2089x1764px.
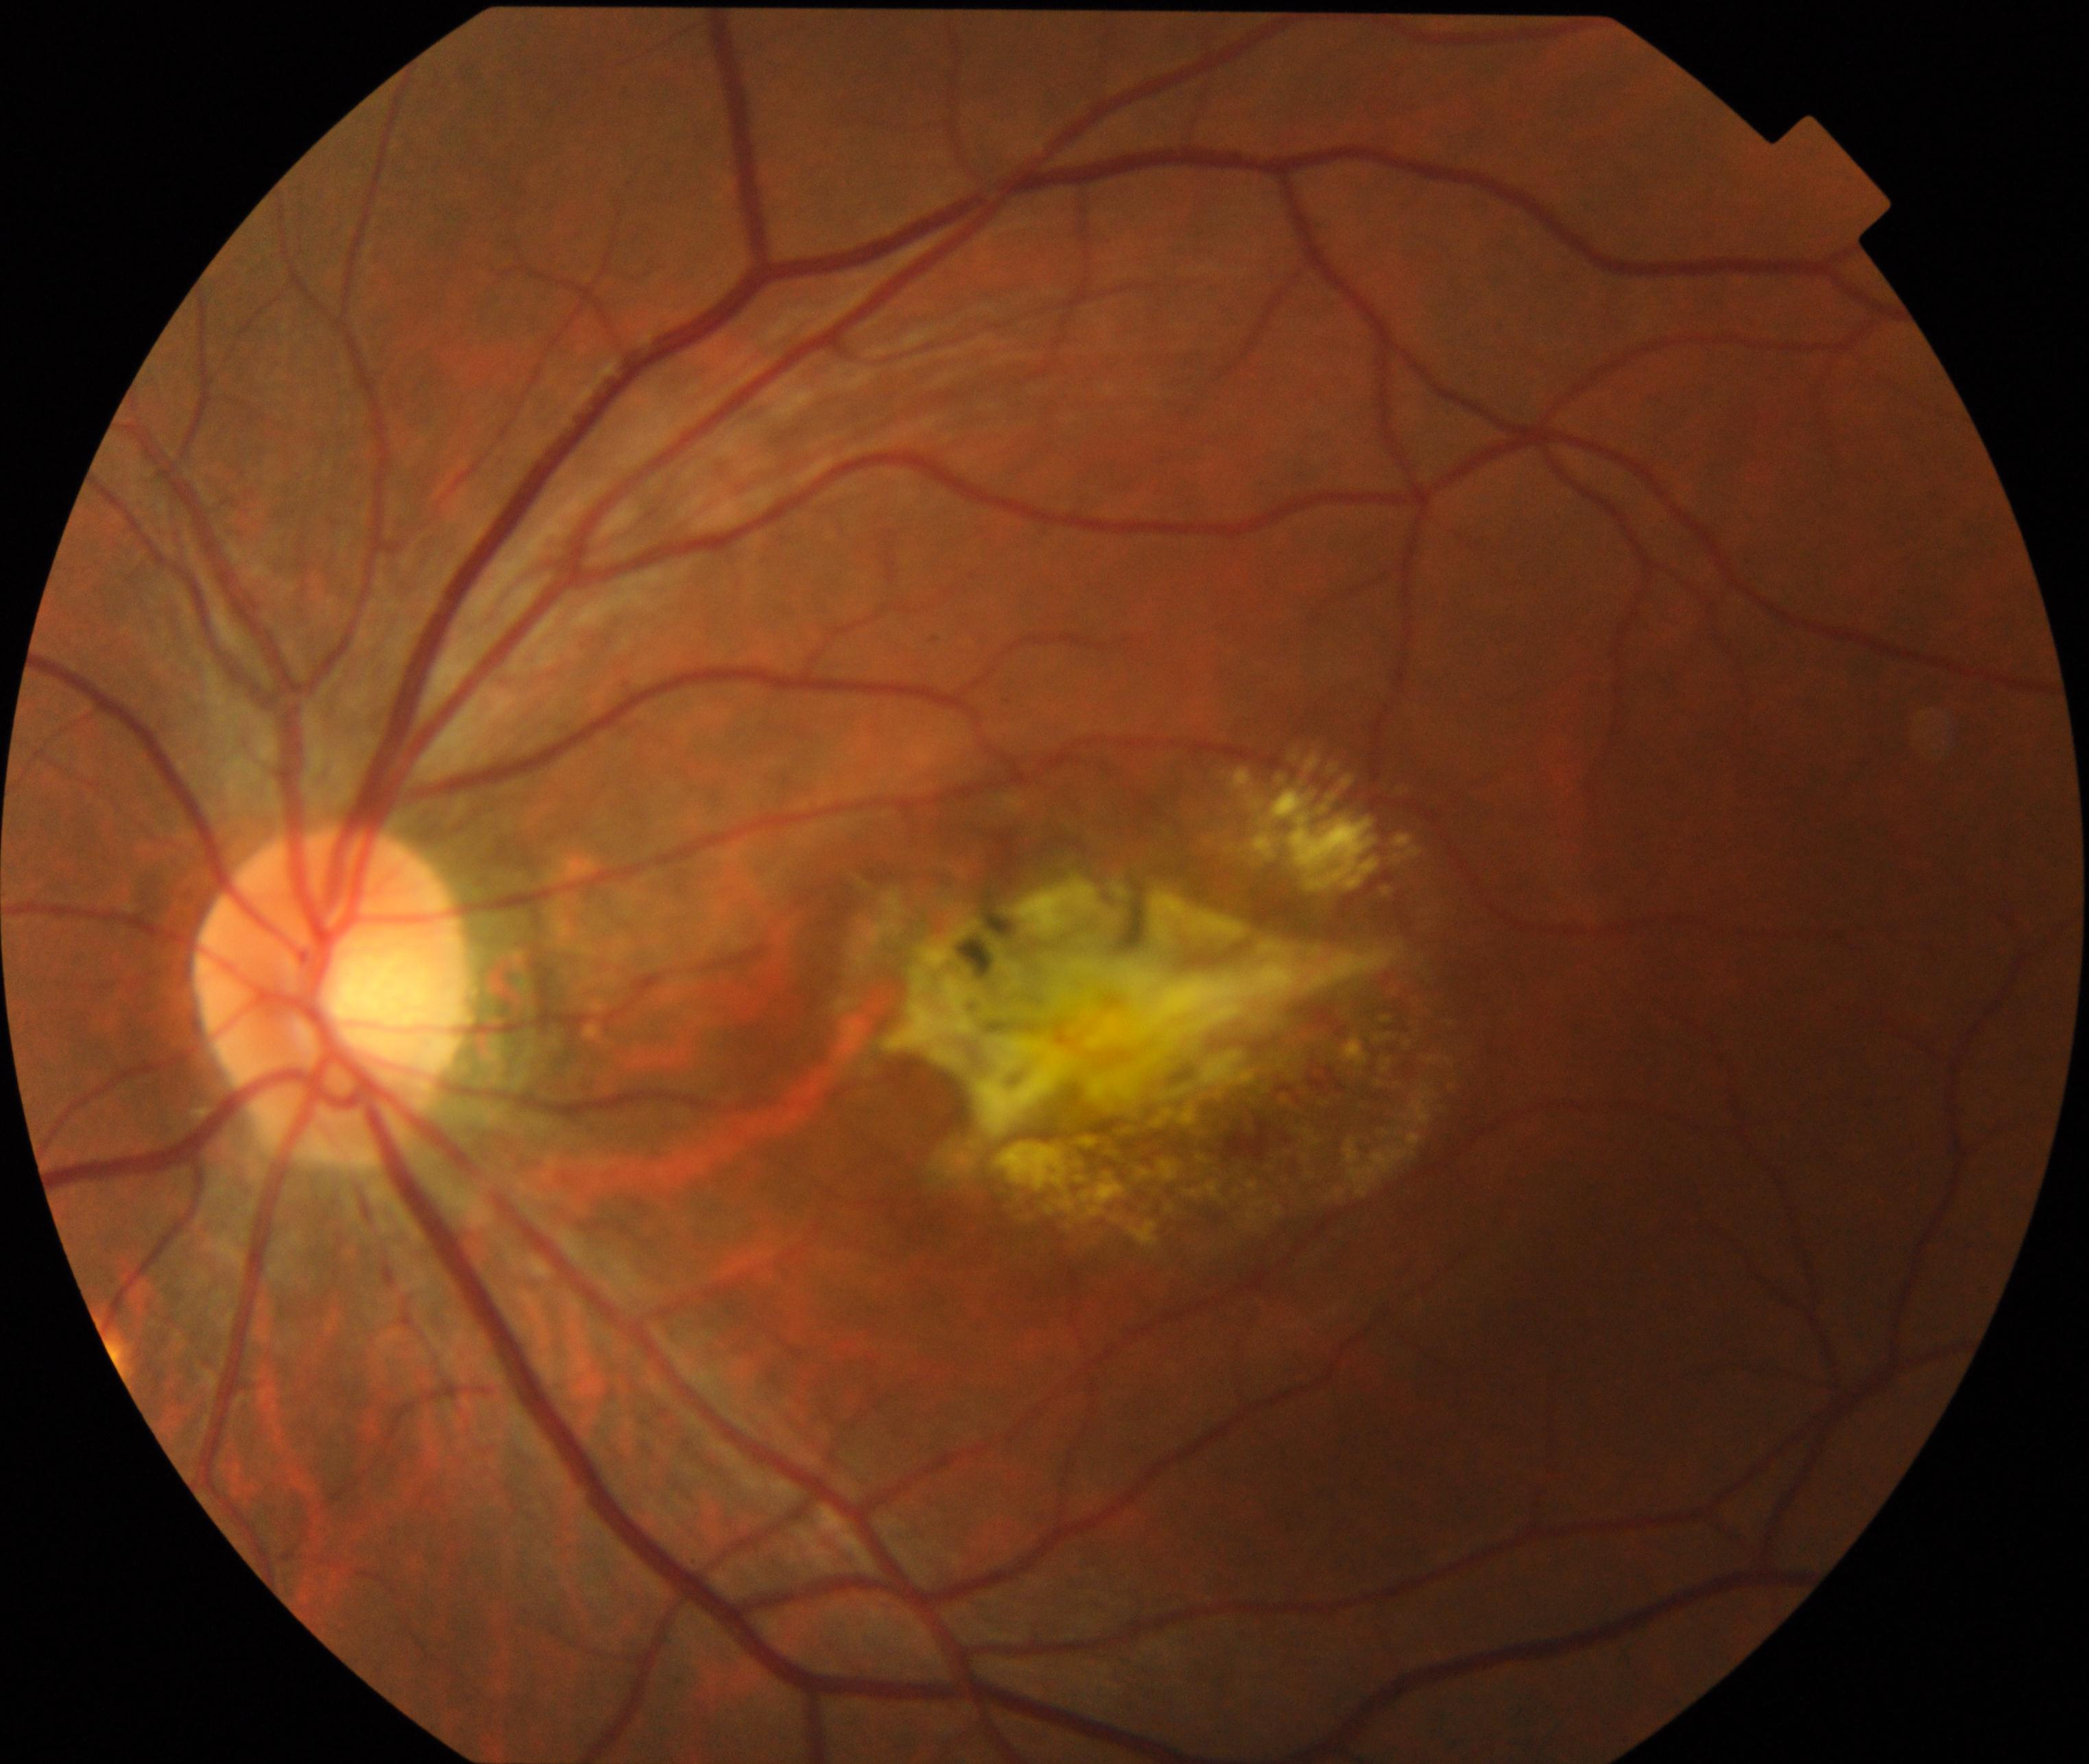
Color fundus photograph showing maculopathy.